Pediatric wide-field fundus photograph.
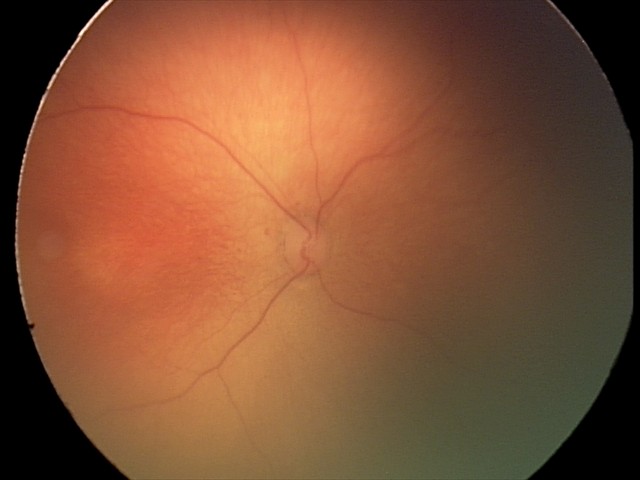

Screening series with retinopathy of prematurity (ROP) stage 1.
Plus disease absent.